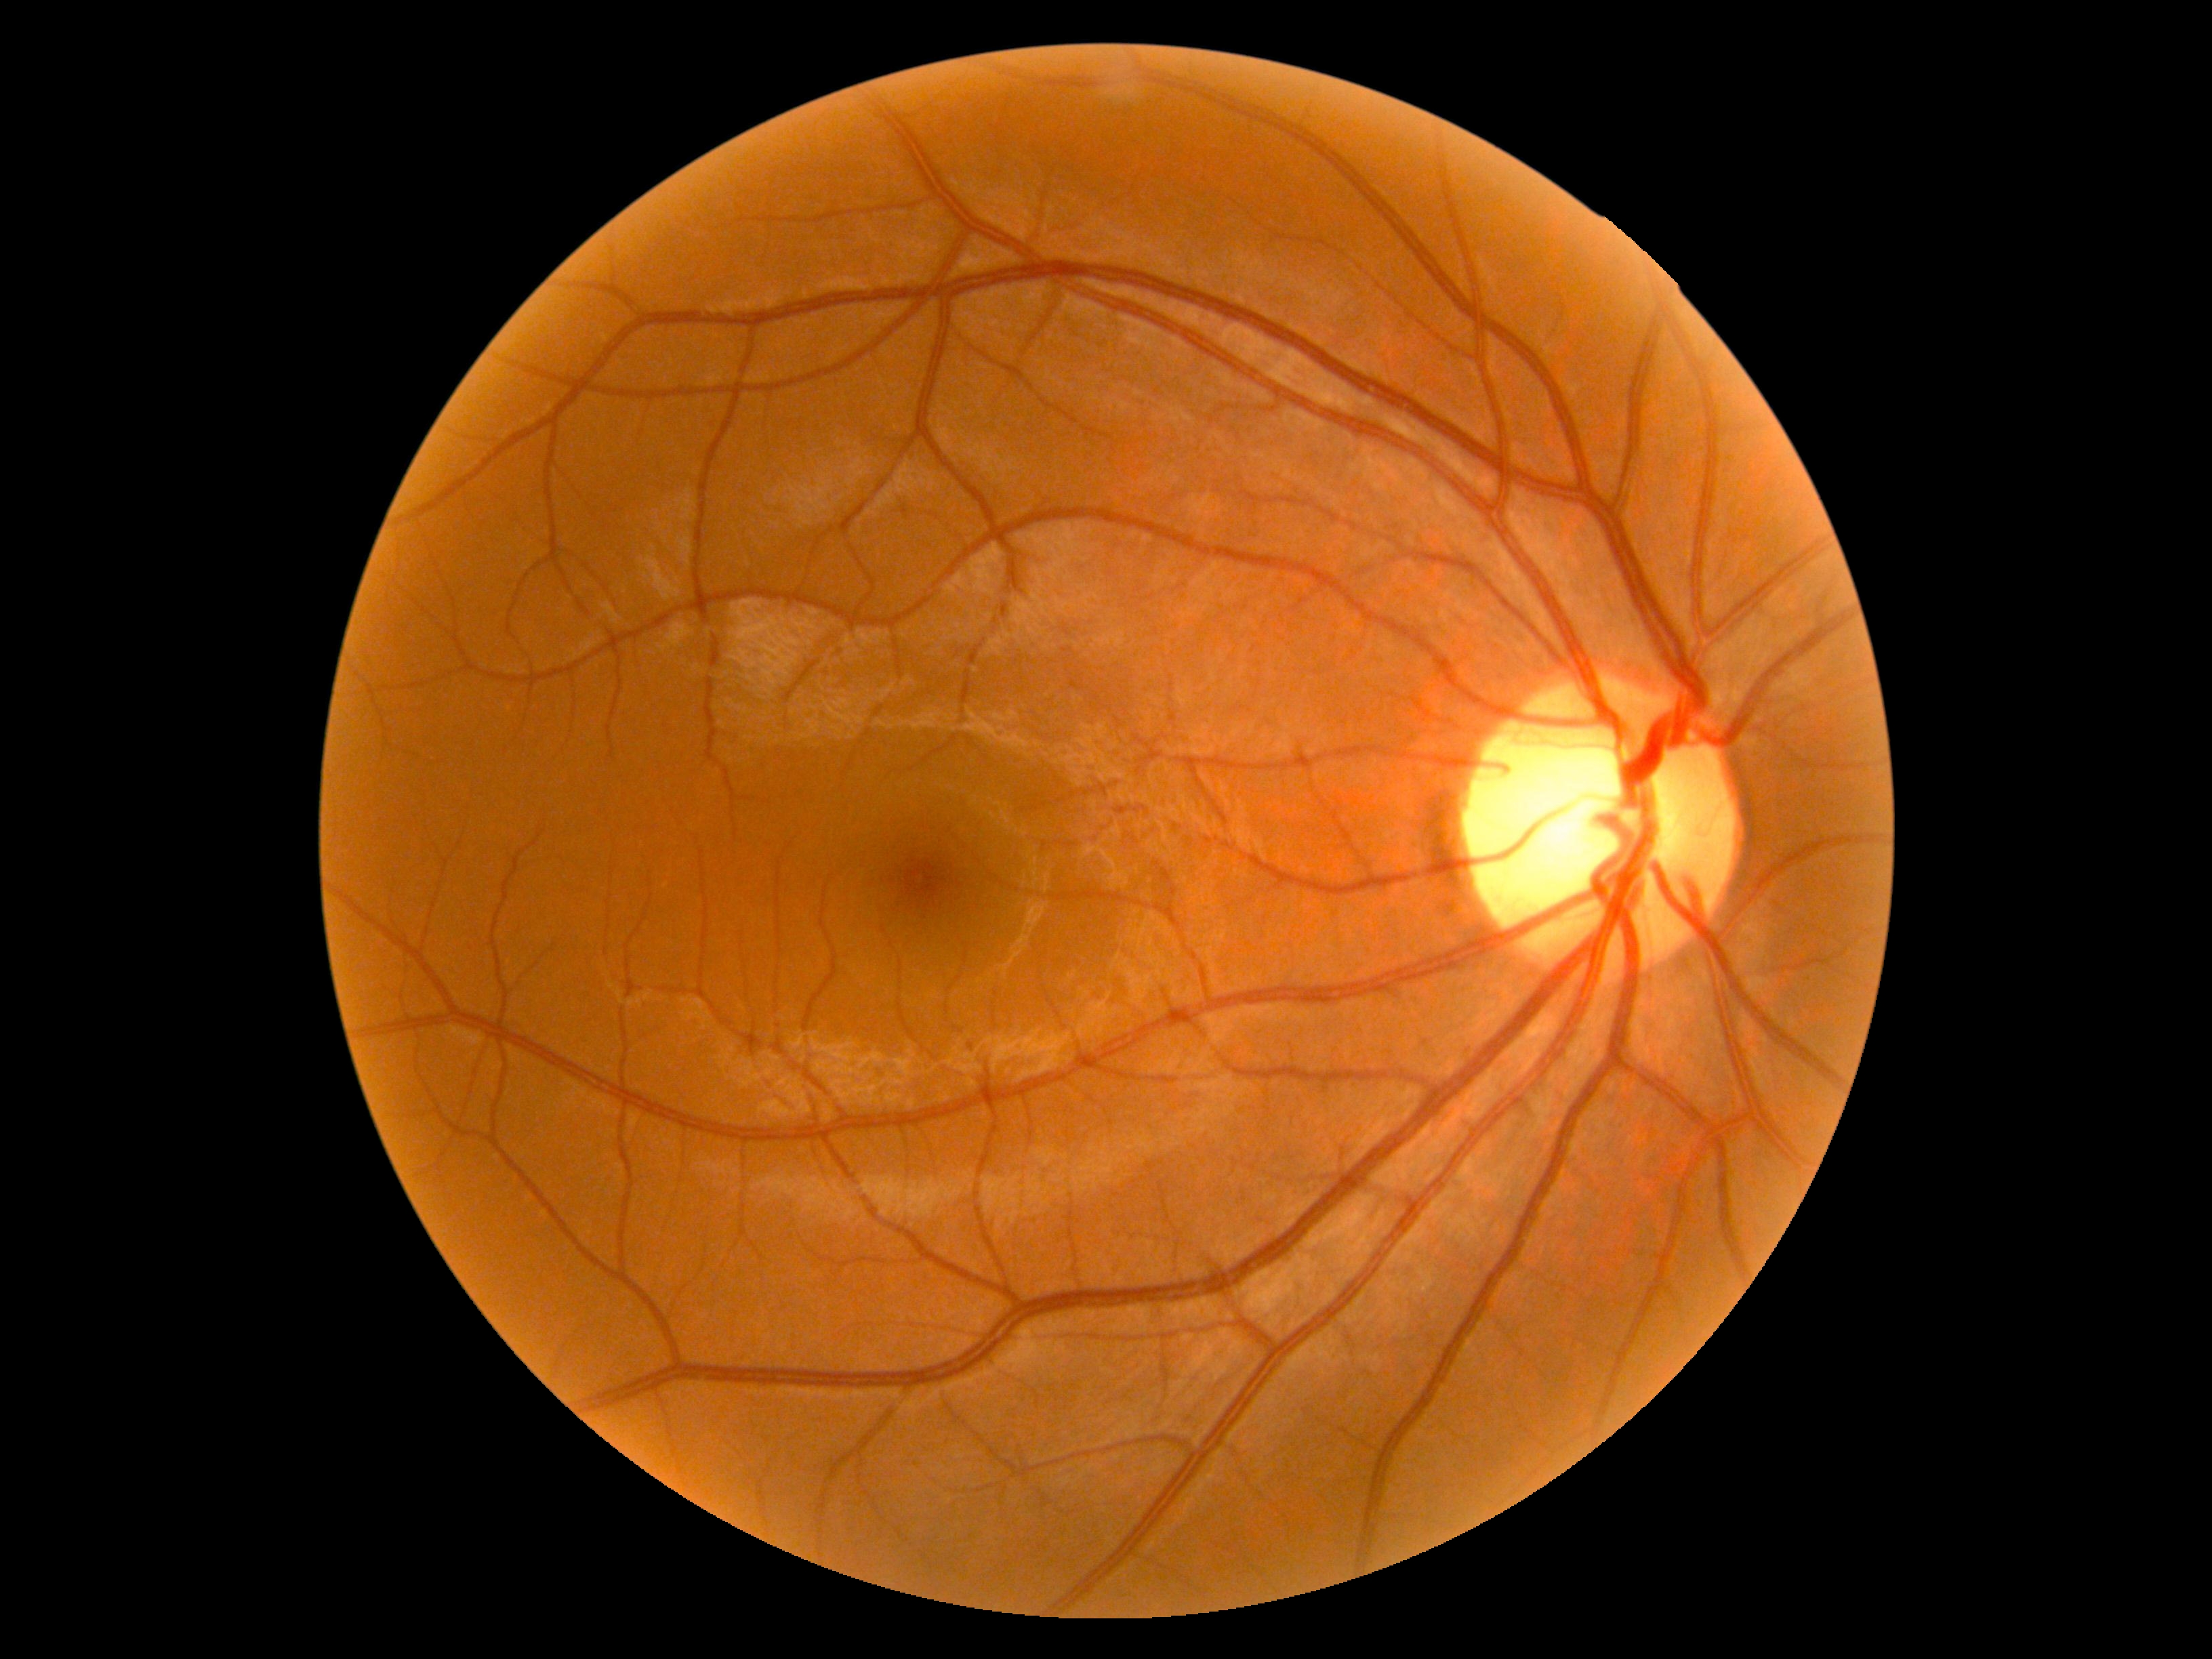

No signs of diabetic retinopathy.
Diabetic retinopathy: no apparent retinopathy (grade 0).